Clarity RetCam 3, 130° FOV. Infant wide-field retinal image. 640x480px — 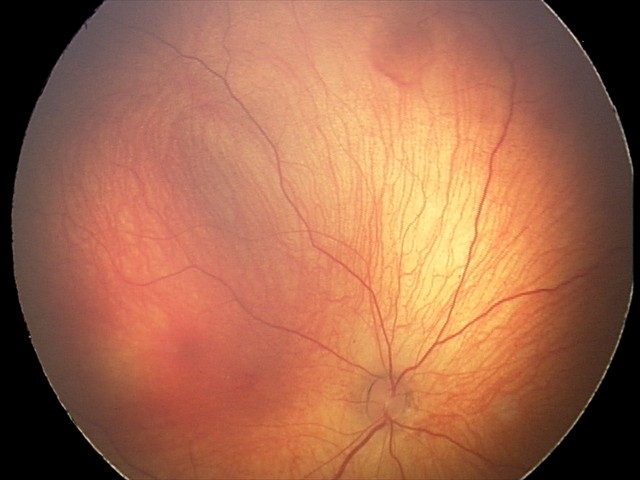 Assessment: retinal hemorrhages.